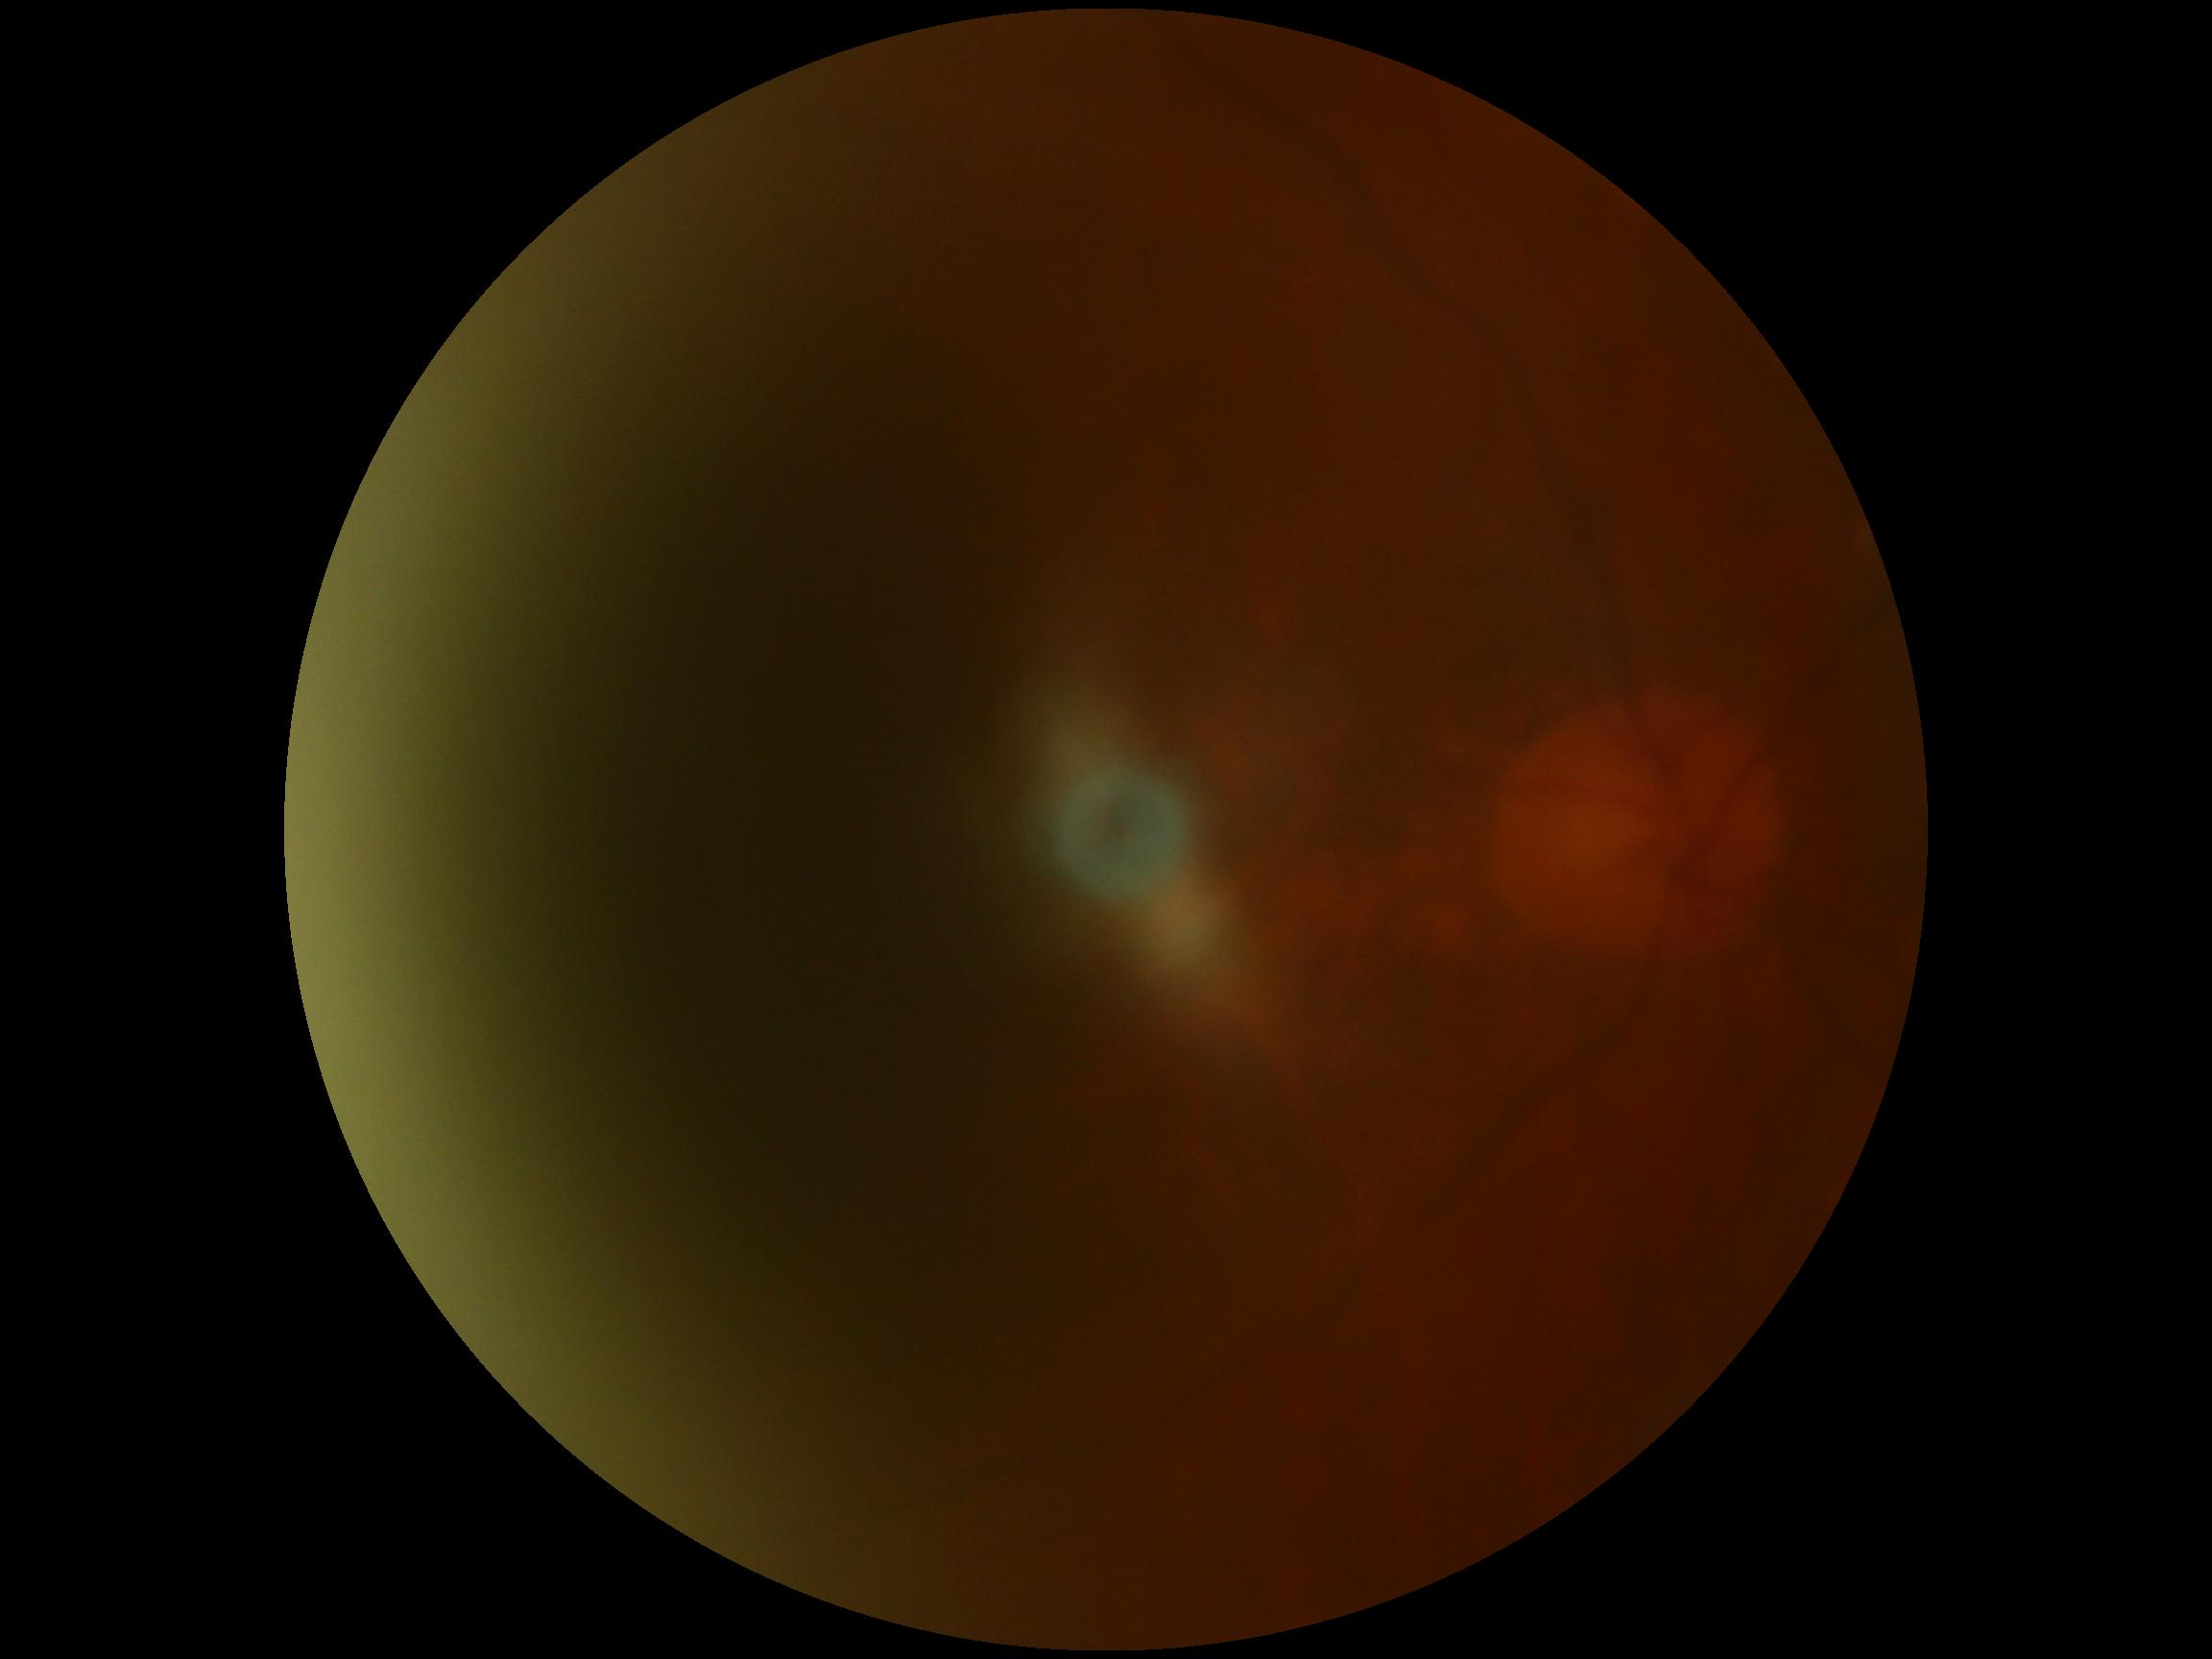 DR severity is ungradable due to poor image quality.